848x848px · modified Davis classification:
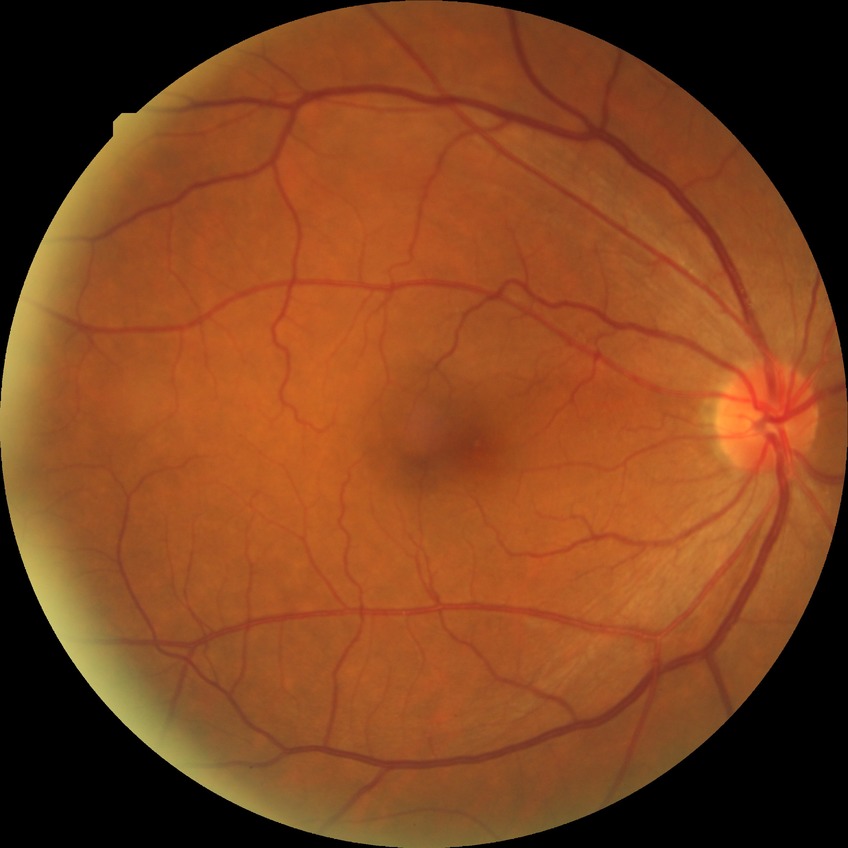
{"davis_grade": "no diabetic retinopathy"}